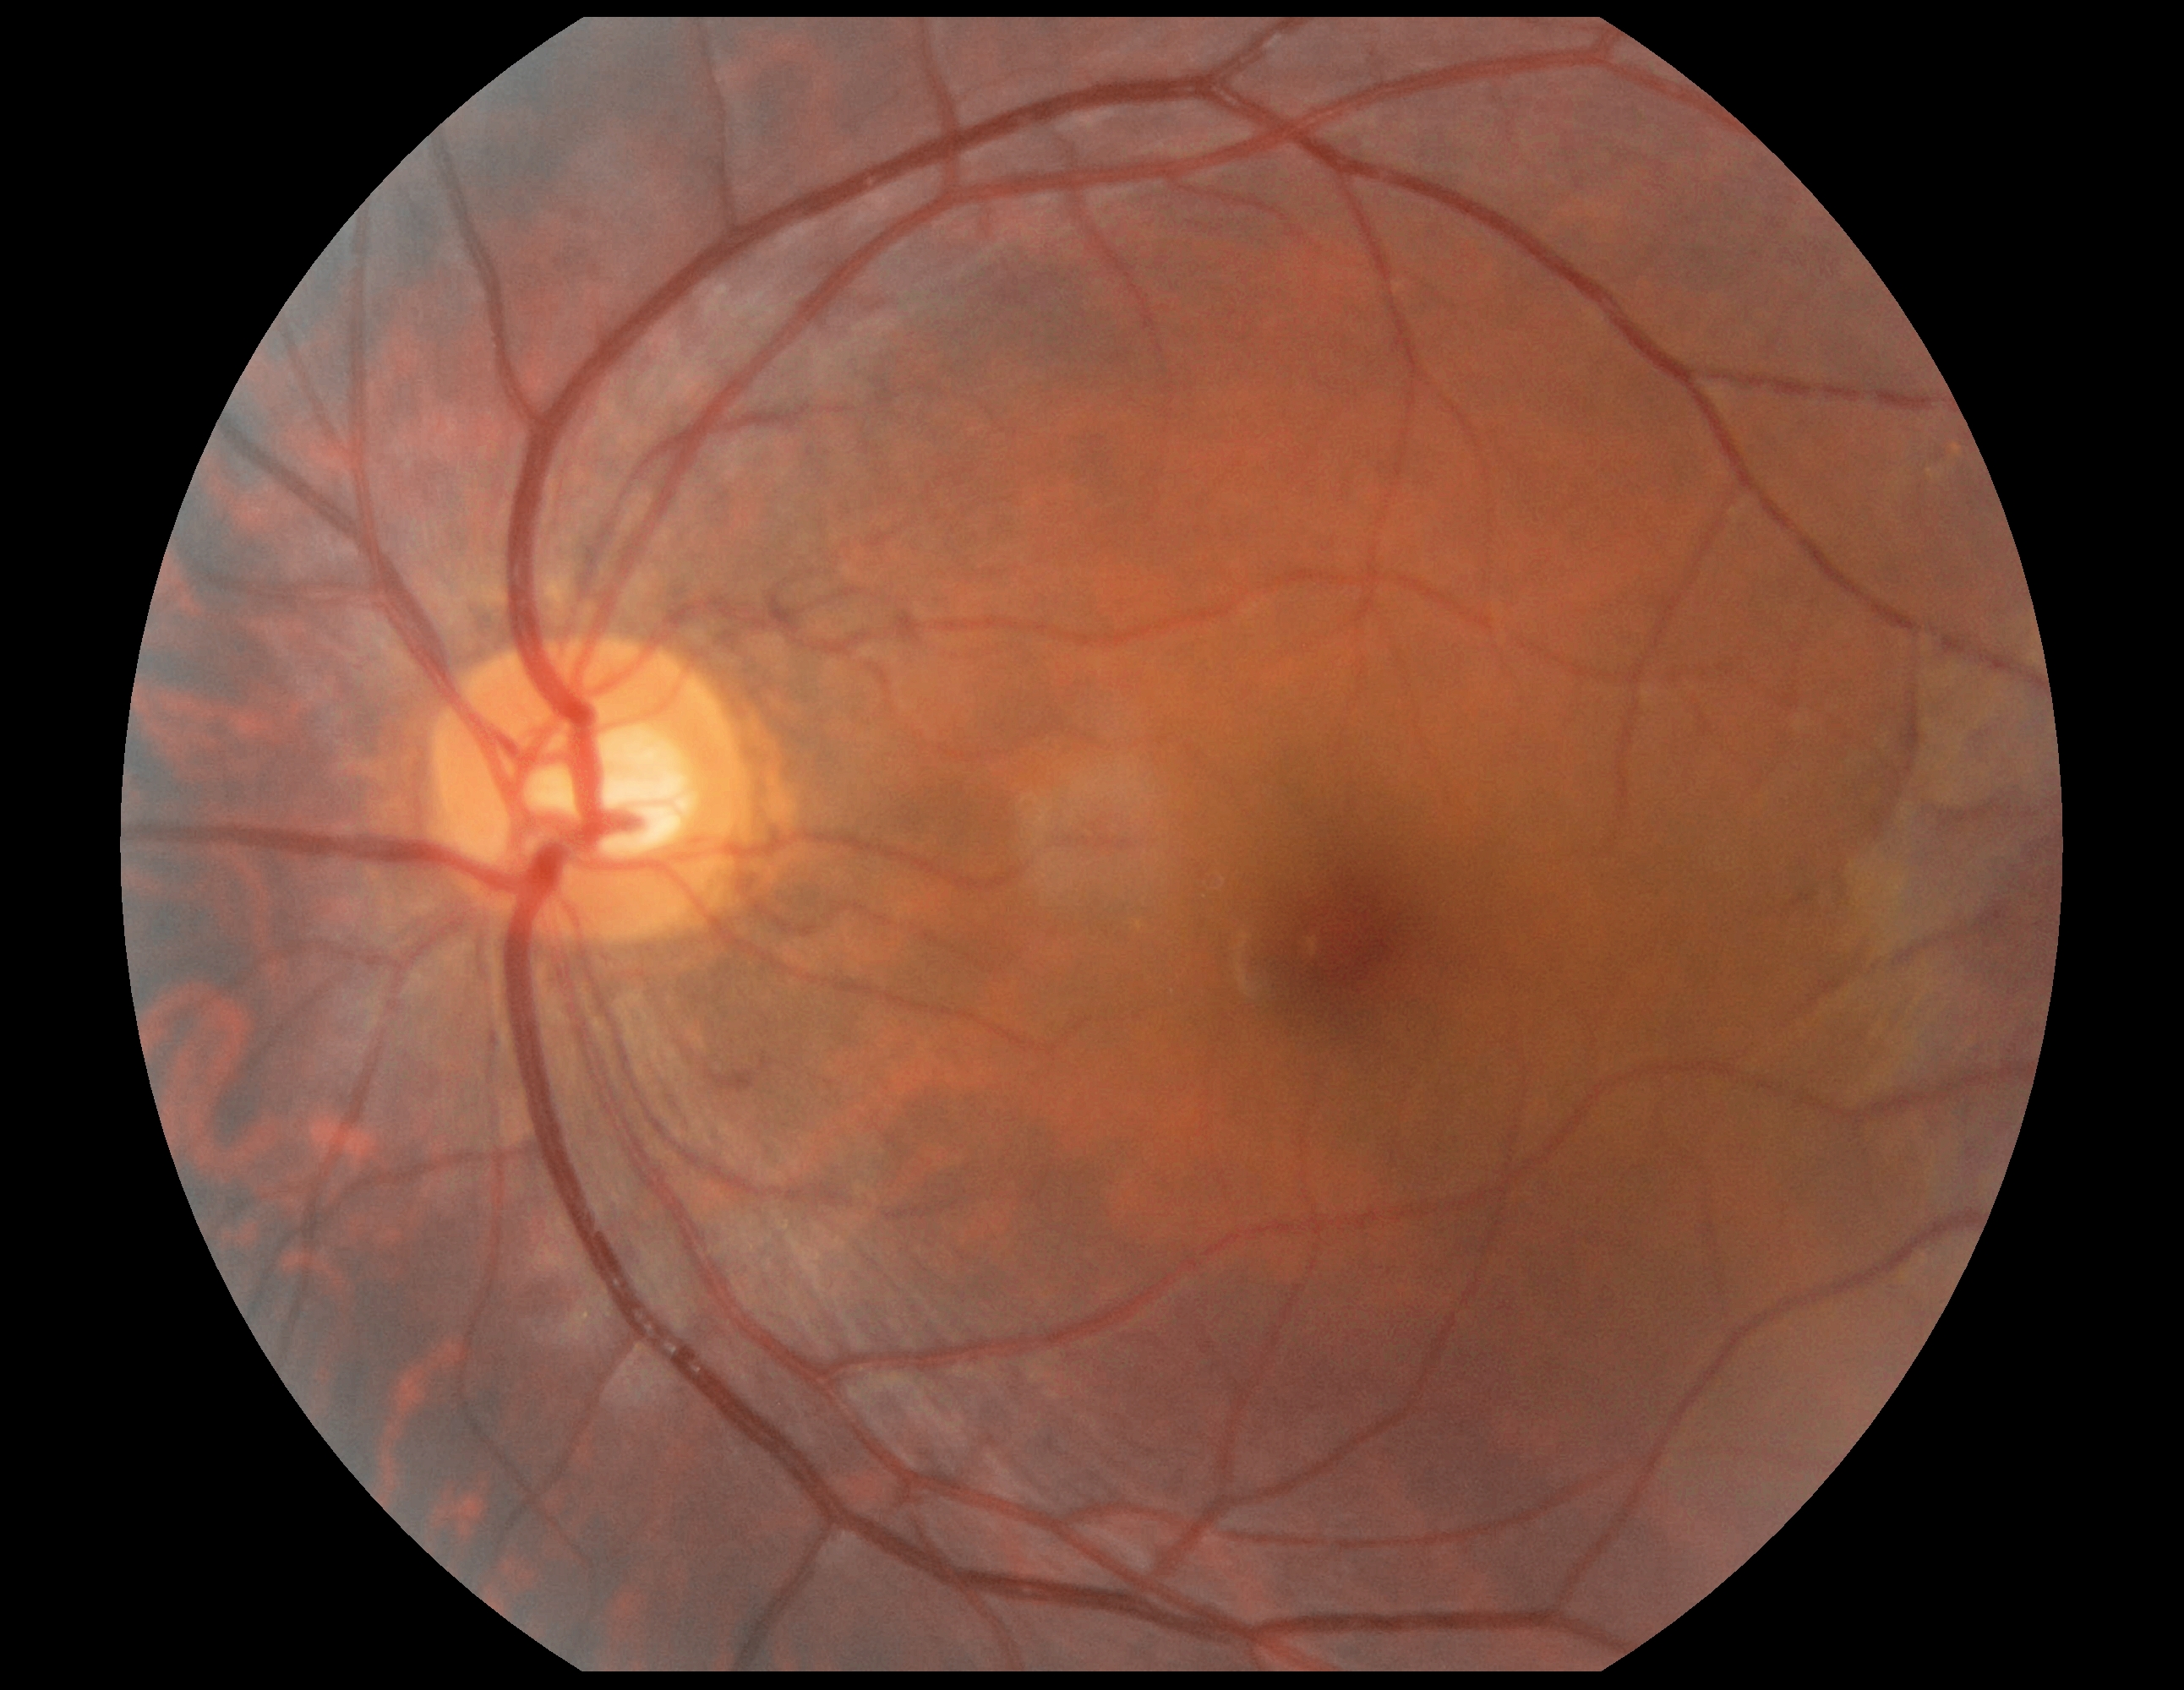
Diabetic retinopathy (DR): grade 0.